Modified Davis classification.
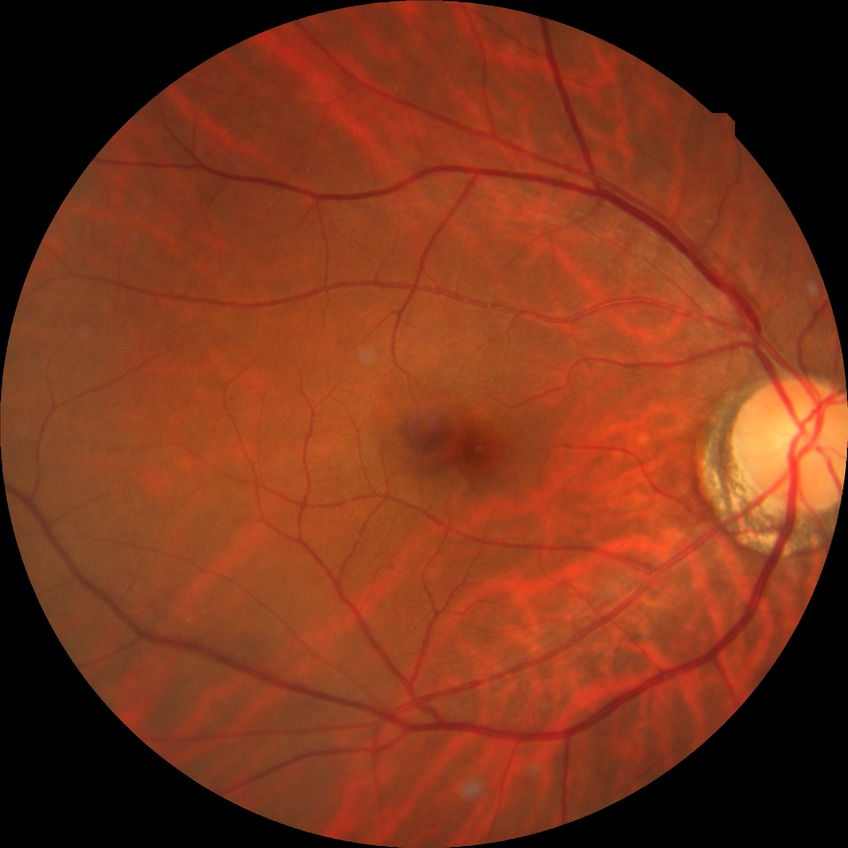   davis_grade: NDR
  dr_impression: no DR findings